Modified Davis classification, nonmydriatic fundus photograph:
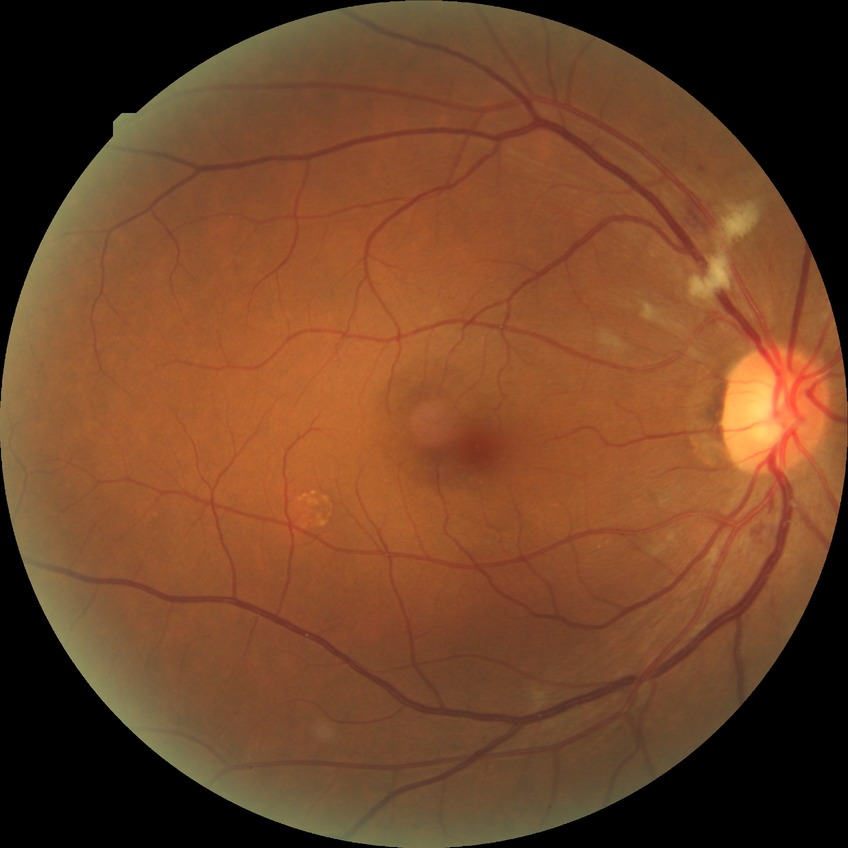 The retinopathy is classified as non-proliferative diabetic retinopathy.
Diabetic retinopathy grade: pre-proliferative diabetic retinopathy.